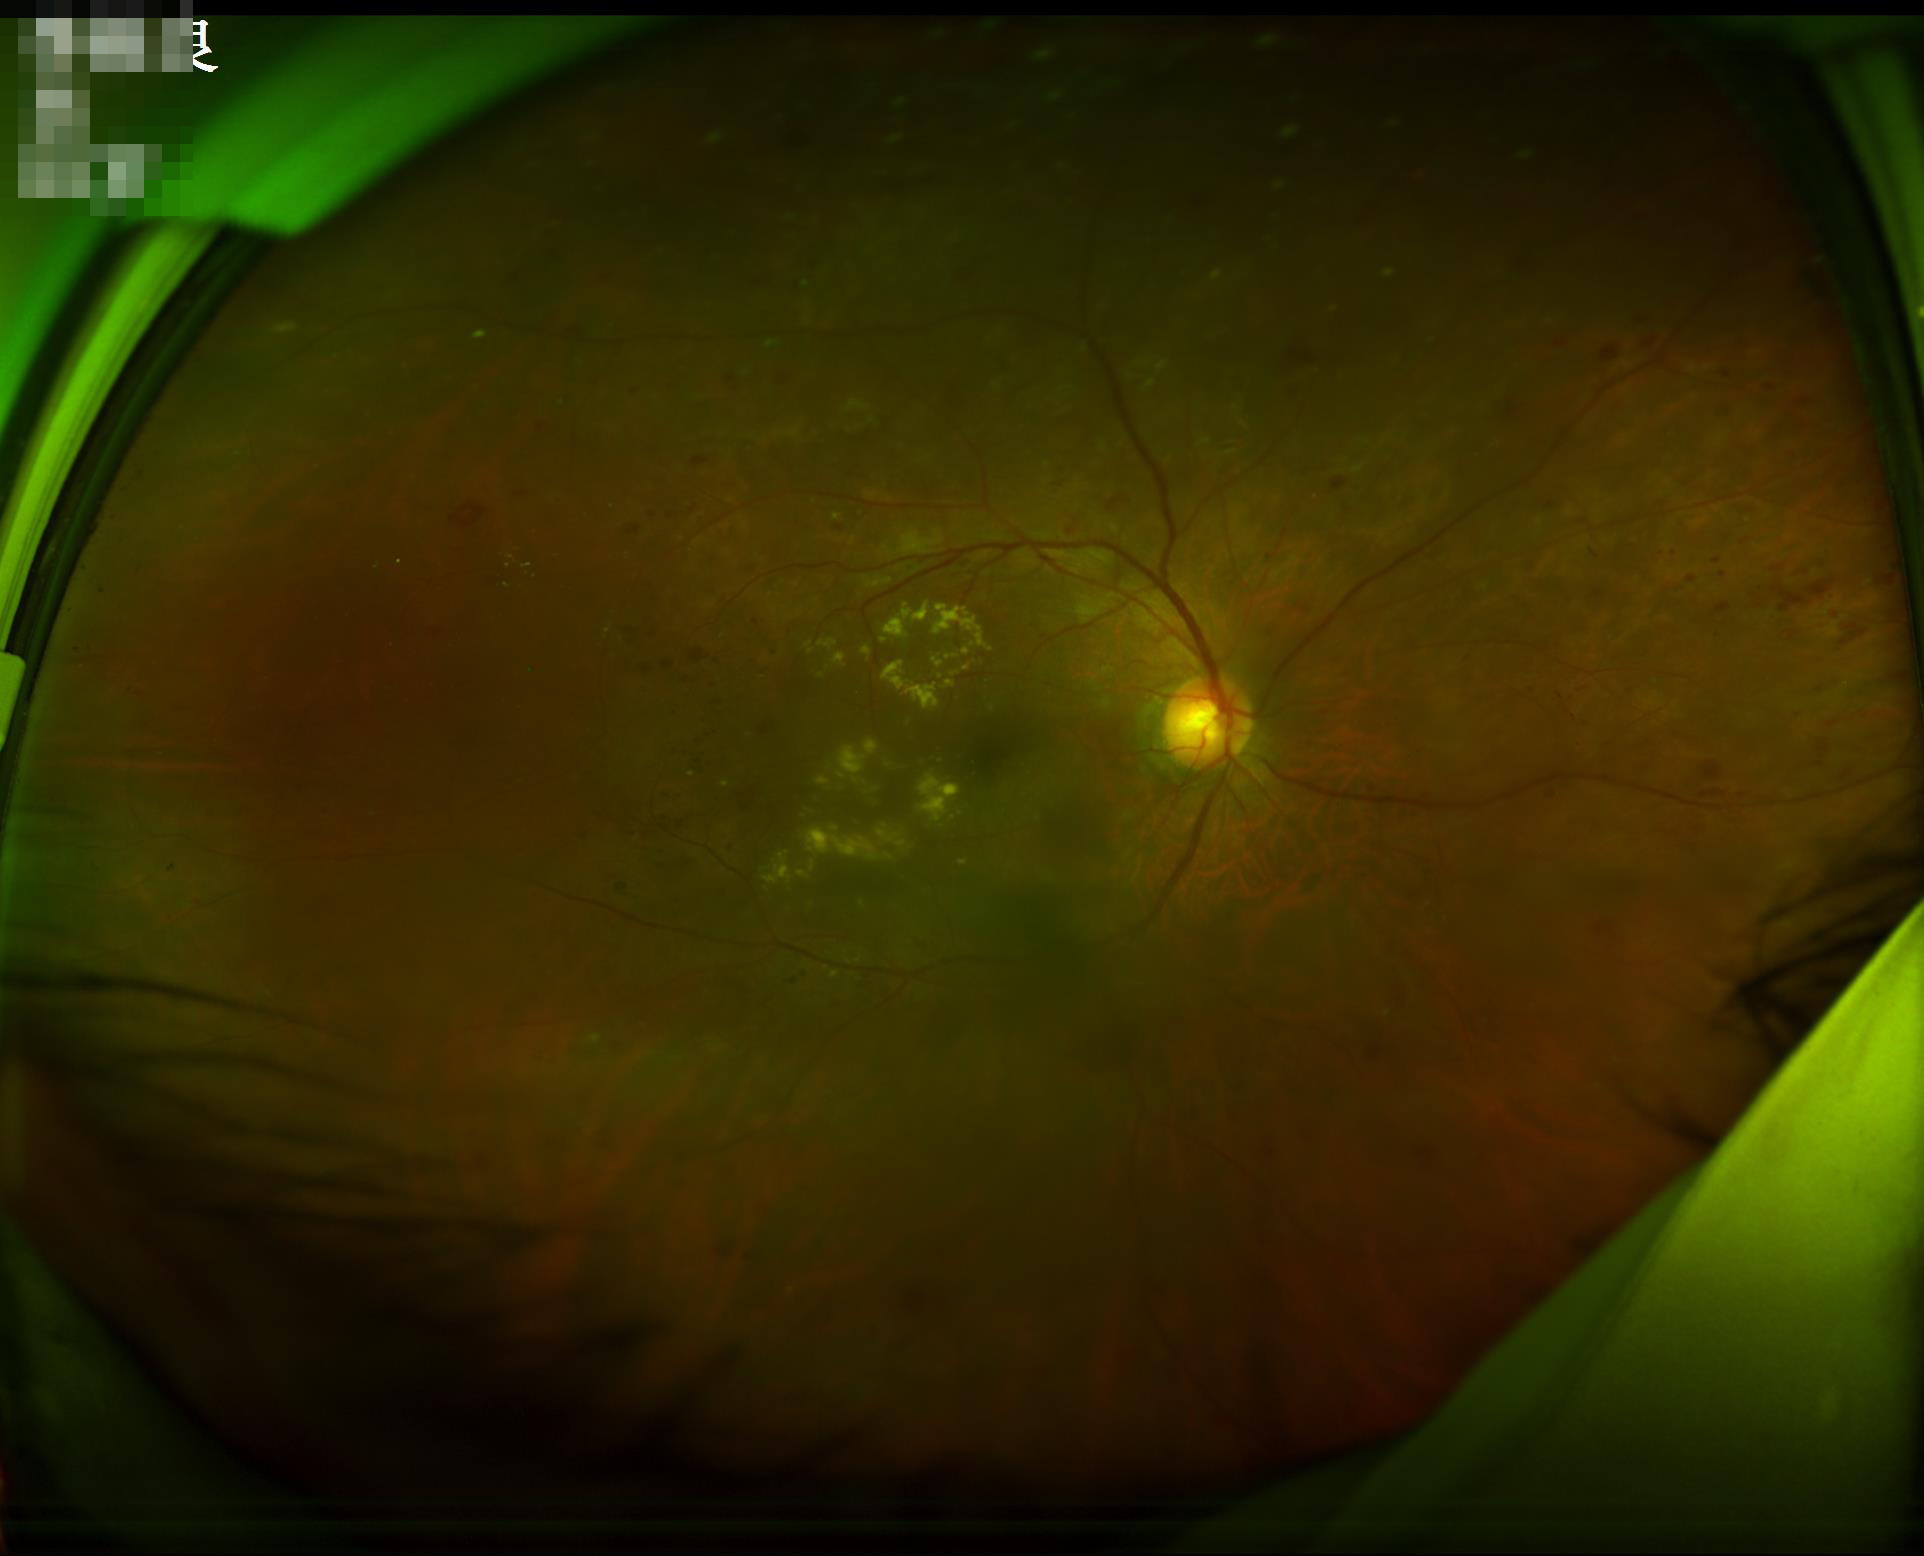
  clarity: good
  illumination: poor
  overall_quality: acceptable